412x310px · retinal fundus photograph.
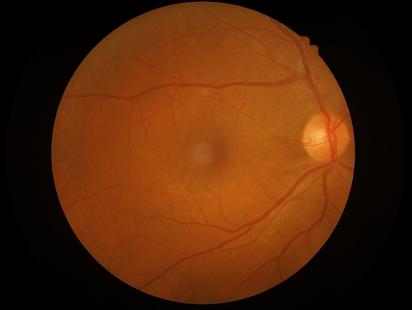

Acceptable image quality. Image is sharp throughout the field. Vessels and details are readily distinguishable. Illumination and color balance are good.